FOV: 45 degrees
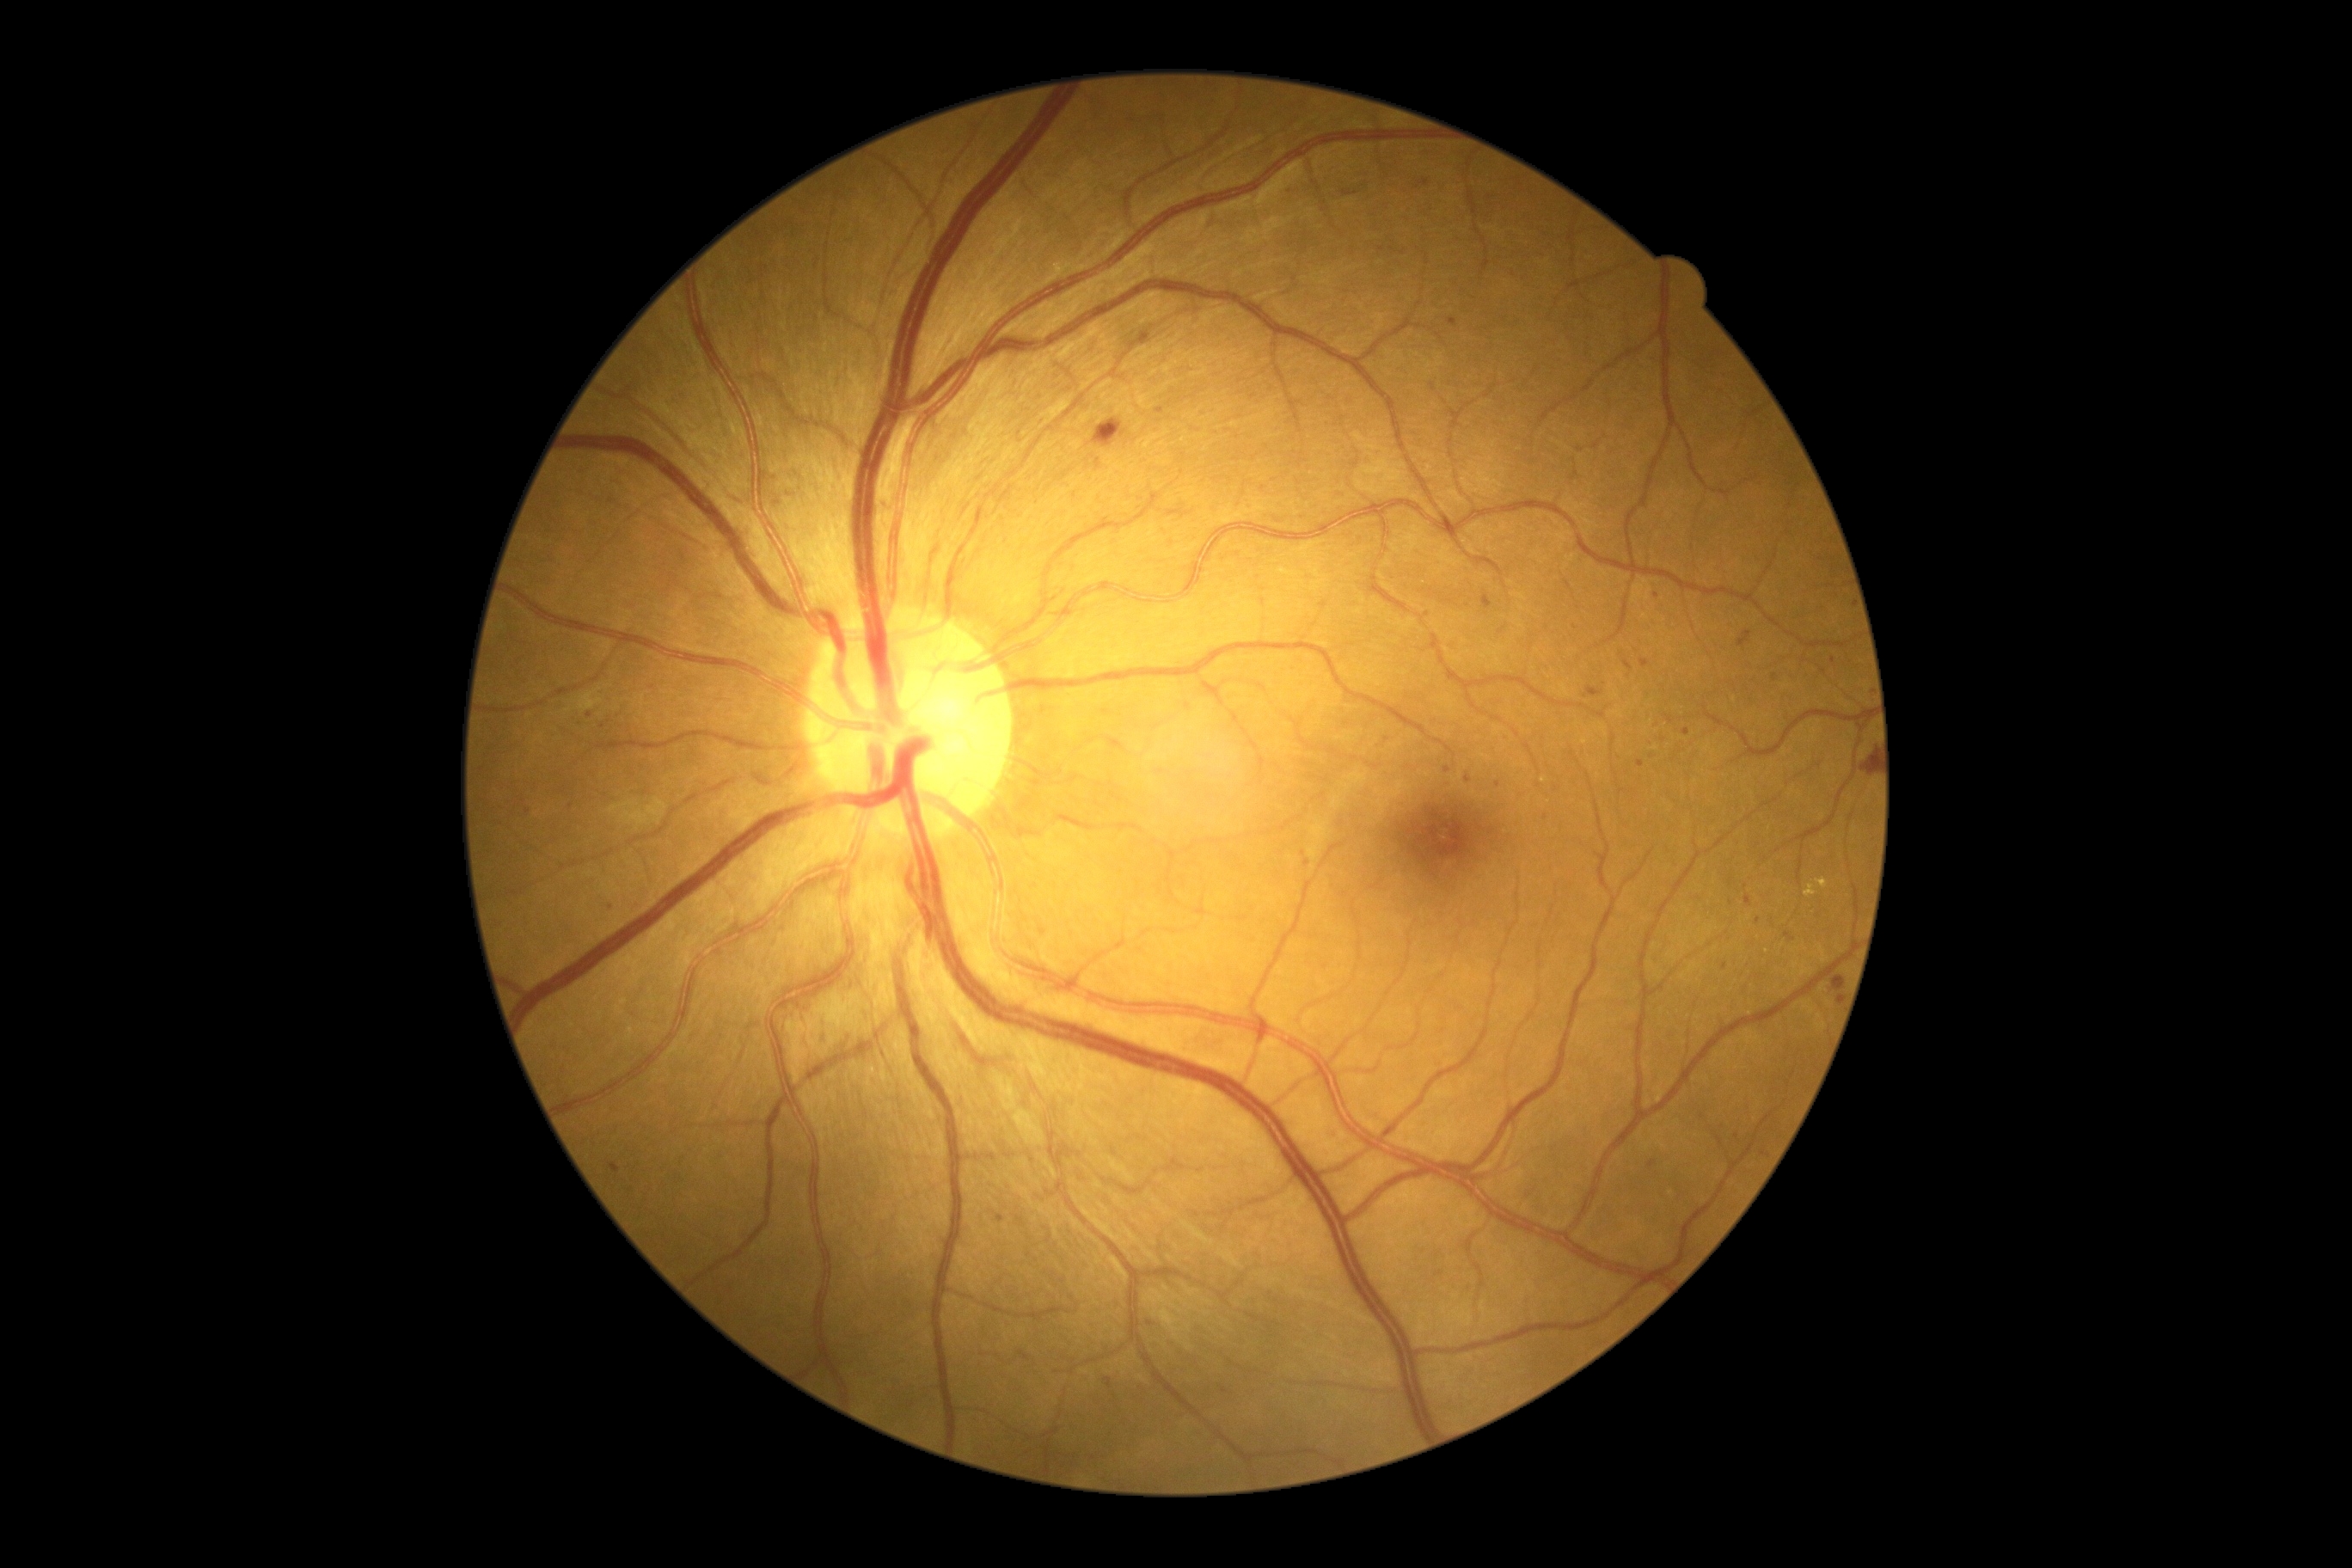 Diabetic retinopathy grade: 2/4
Selected lesions:
microaneurysms (partial): region(1785, 933, 1794, 941), region(1624, 659, 1632, 673), region(1483, 594, 1493, 609), region(1156, 408, 1165, 415), region(1447, 319, 1457, 328)
Small microaneurysms near (774, 479), (1150, 1323), (1764, 1154), (1731, 881), (1426, 616), (1685, 733), (1545, 817), (1664, 740), (590, 715)